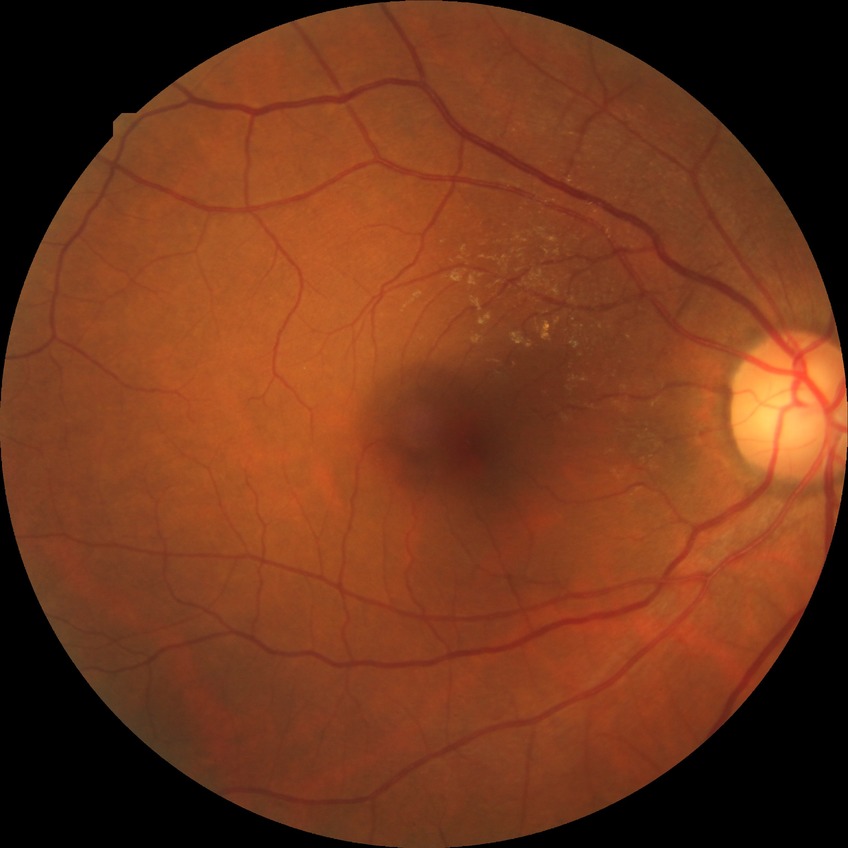
Assessment:
- modified Davis classification — no diabetic retinopathy